Optic disc-centered crop from a color fundus photograph · 301x301px — 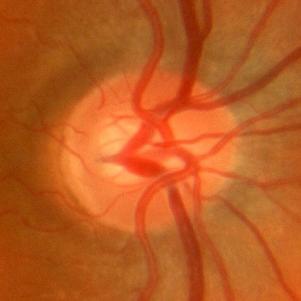 Findings consistent with no glaucomatous optic neuropathy.